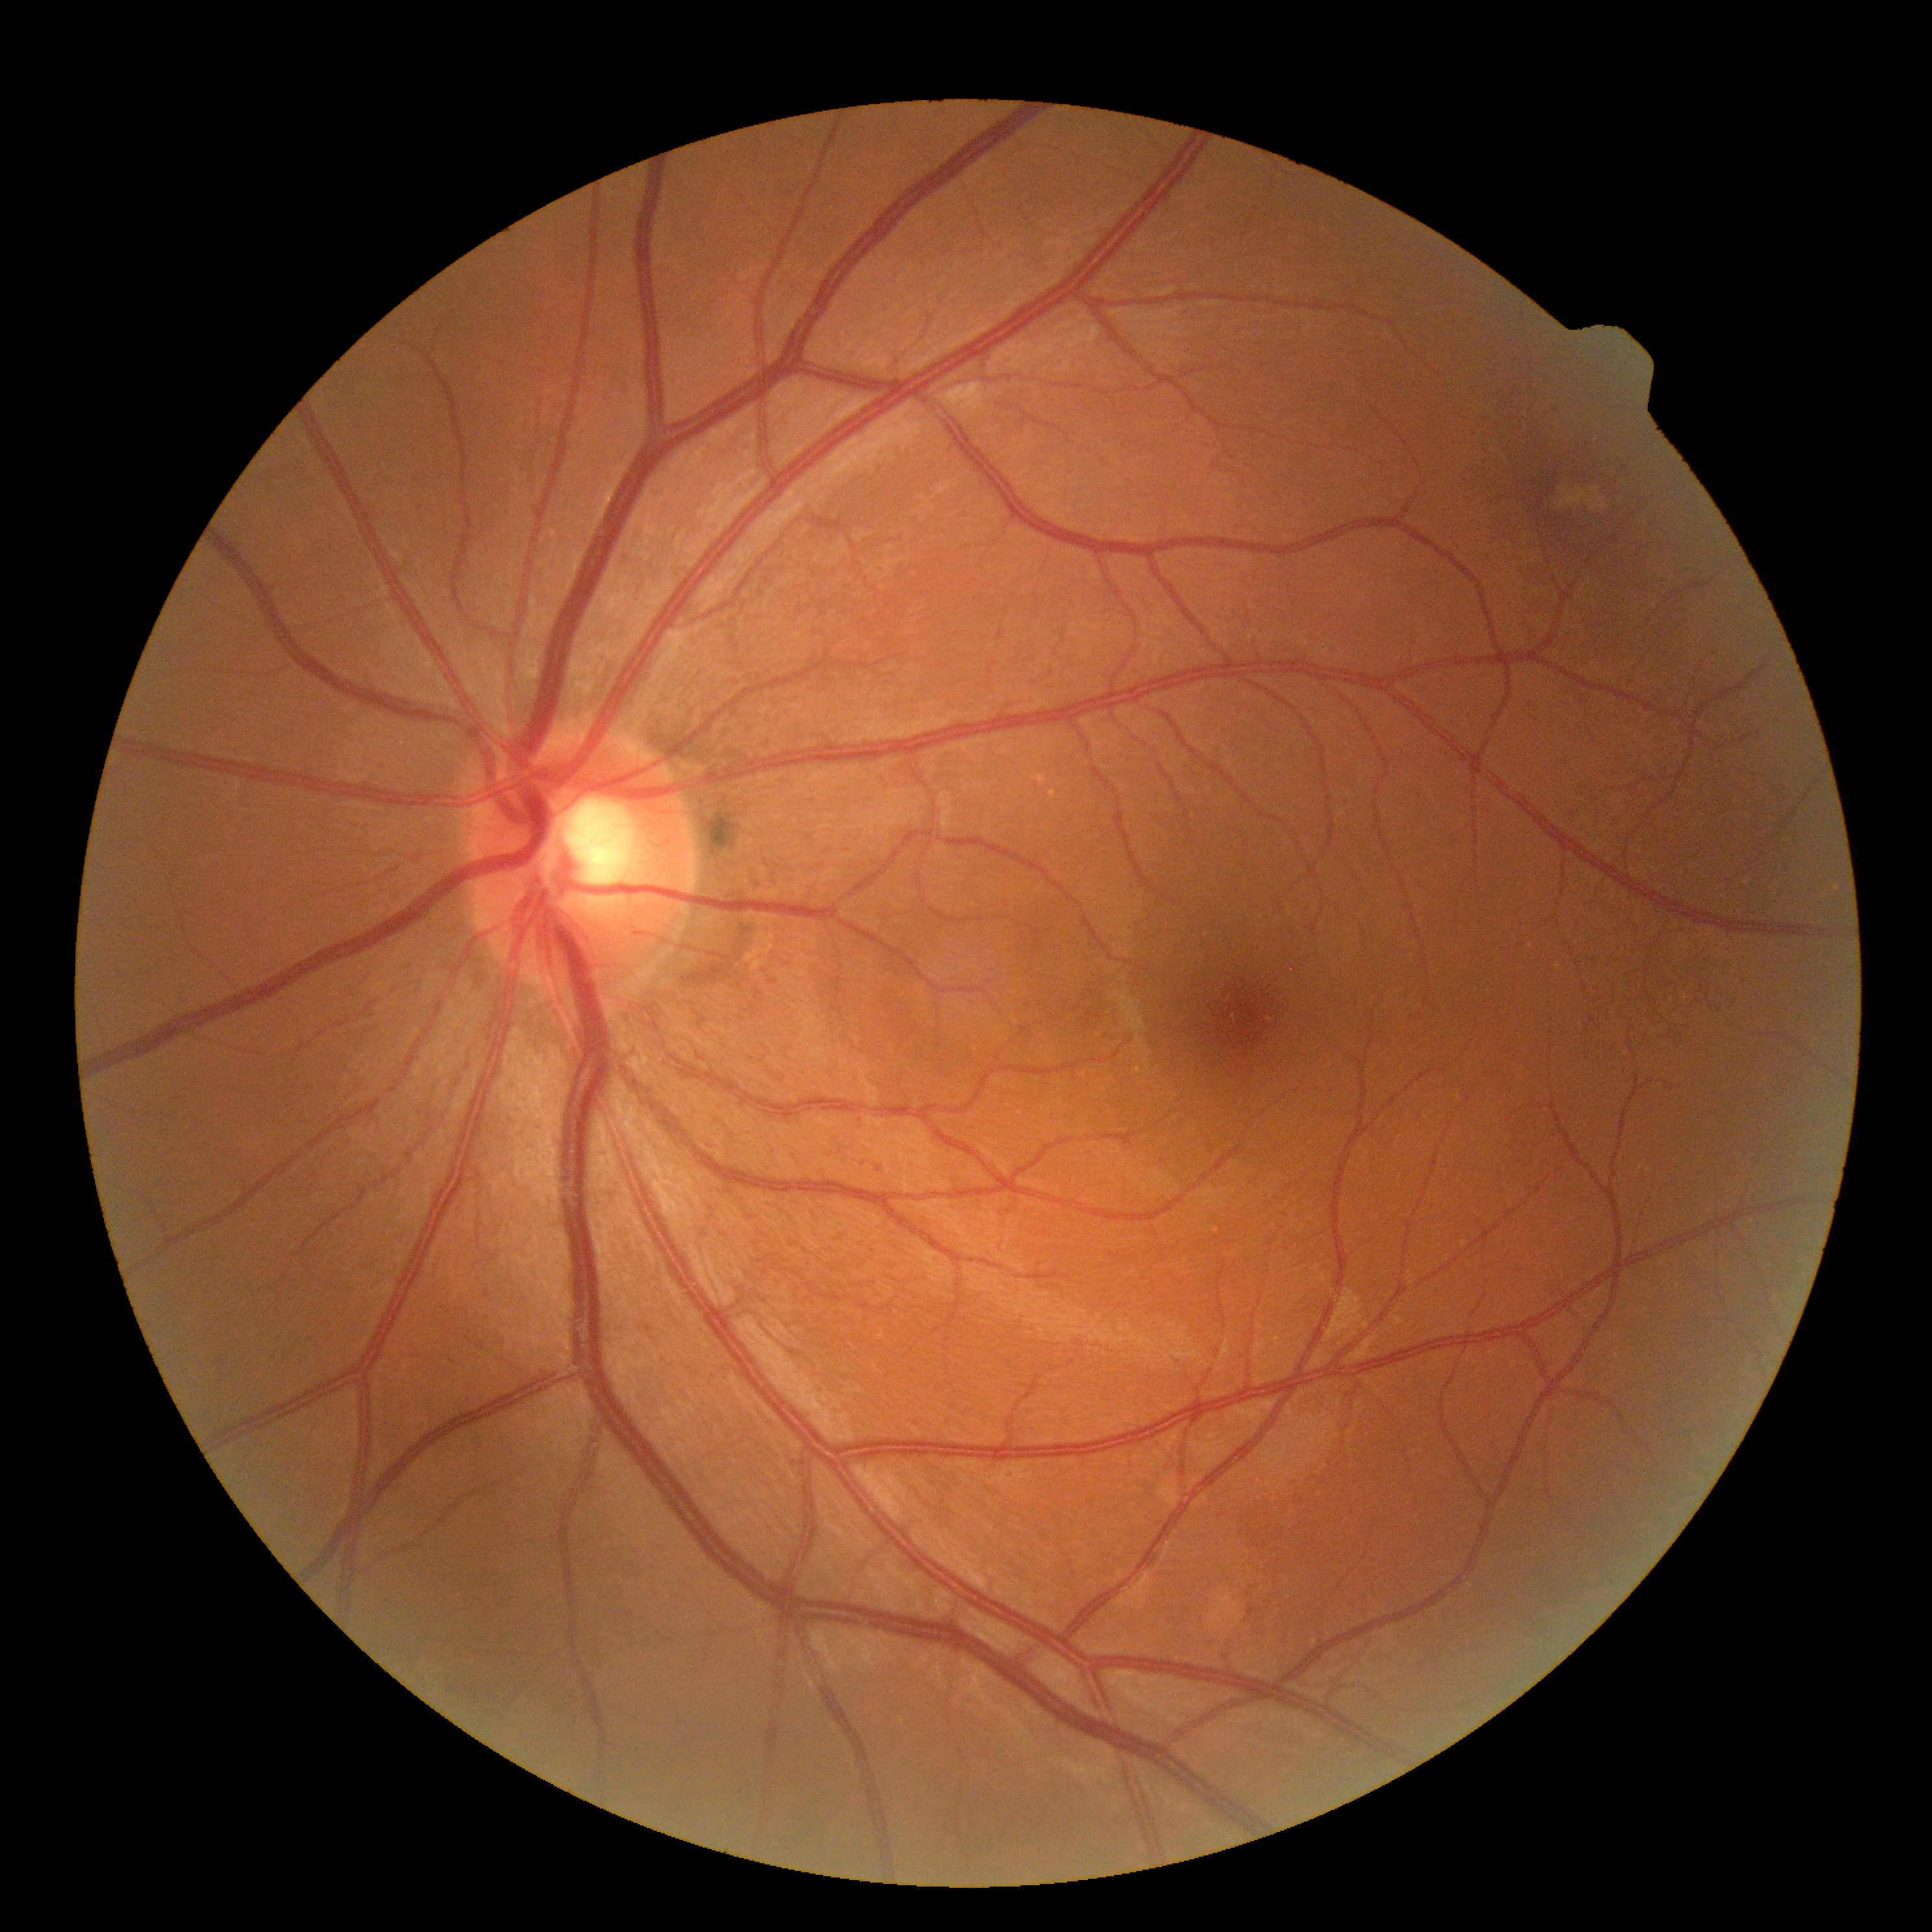 No DR findings. DR: grade 0 (no apparent retinopathy).